Modified Davis classification · no pharmacologic dilation · 848 x 848 pixels · 45 degree fundus photograph — 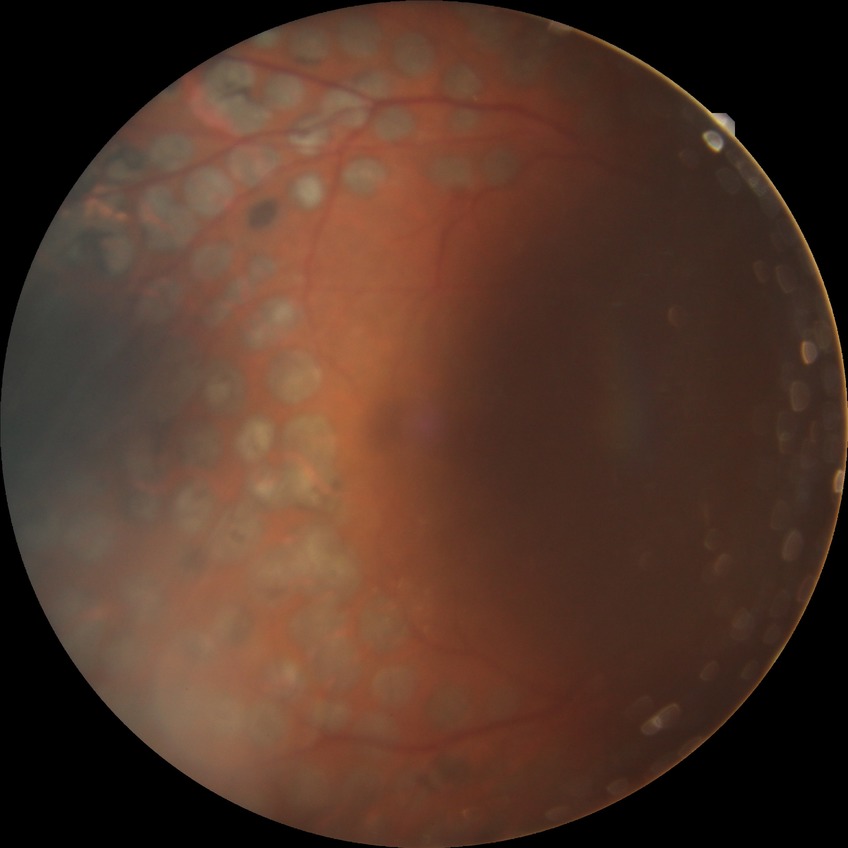
DR stage: PDR.